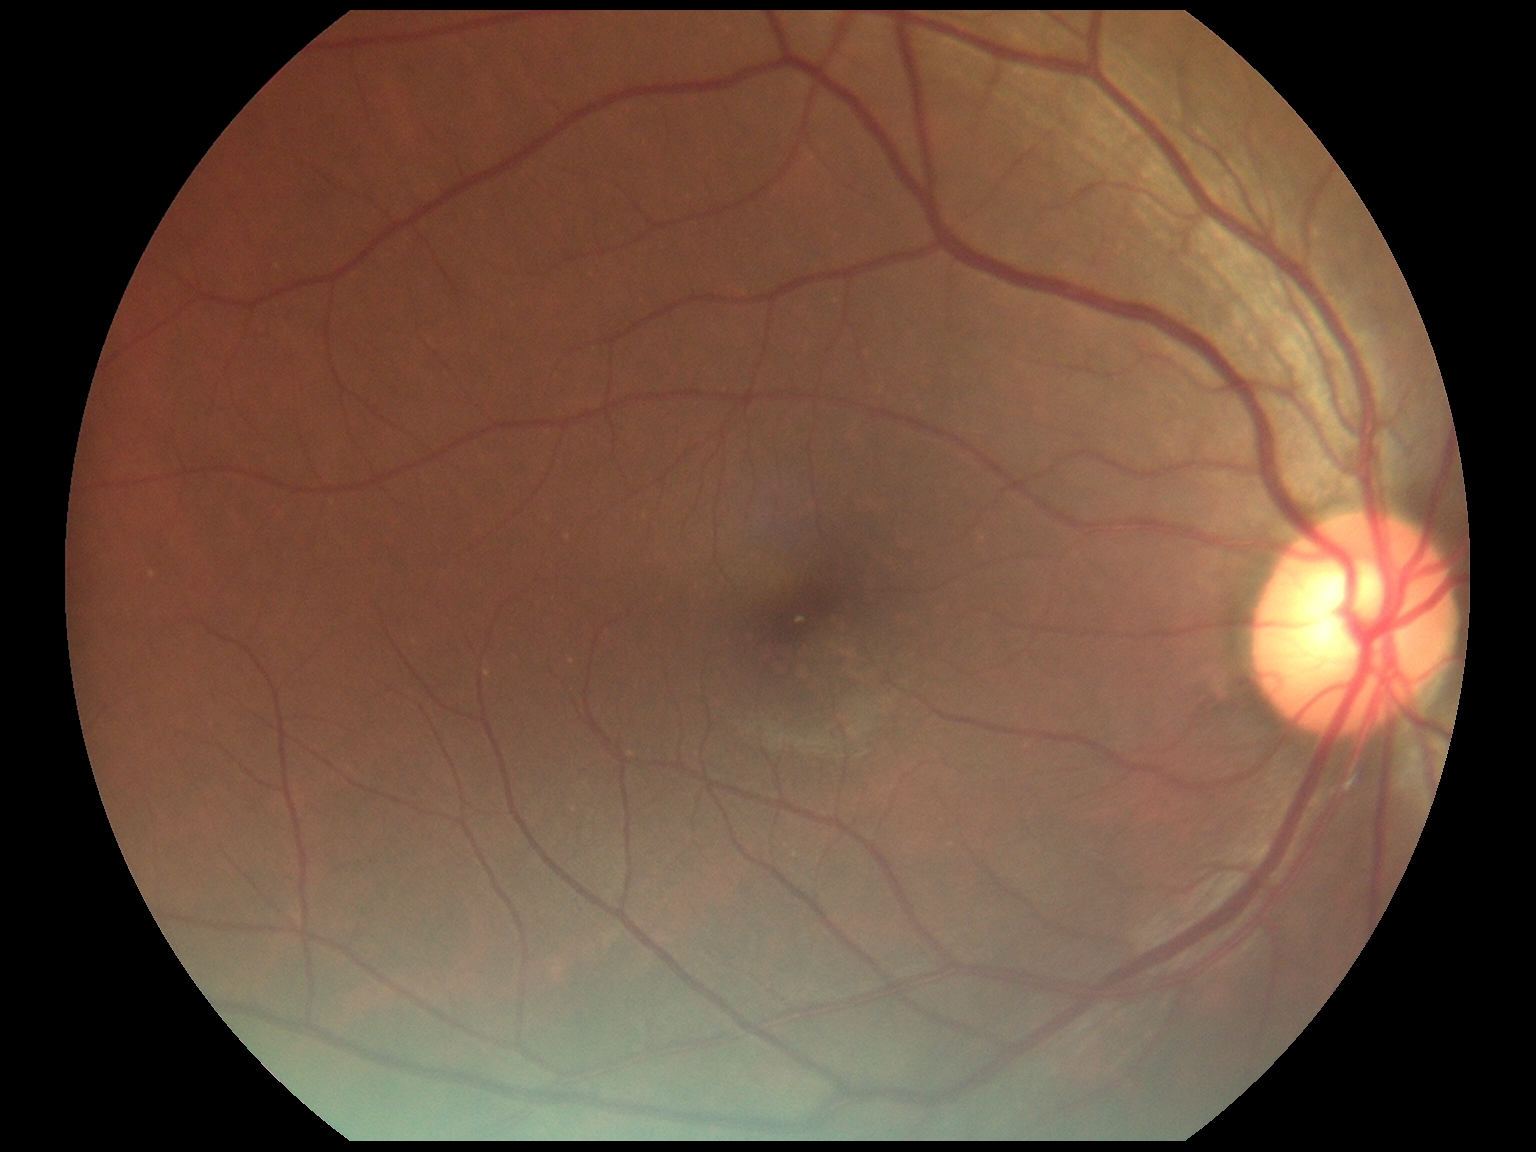

No diabetic retinal disease findings. Diabetic retinopathy: grade 0.